2352x1568px, retinal fundus photograph:
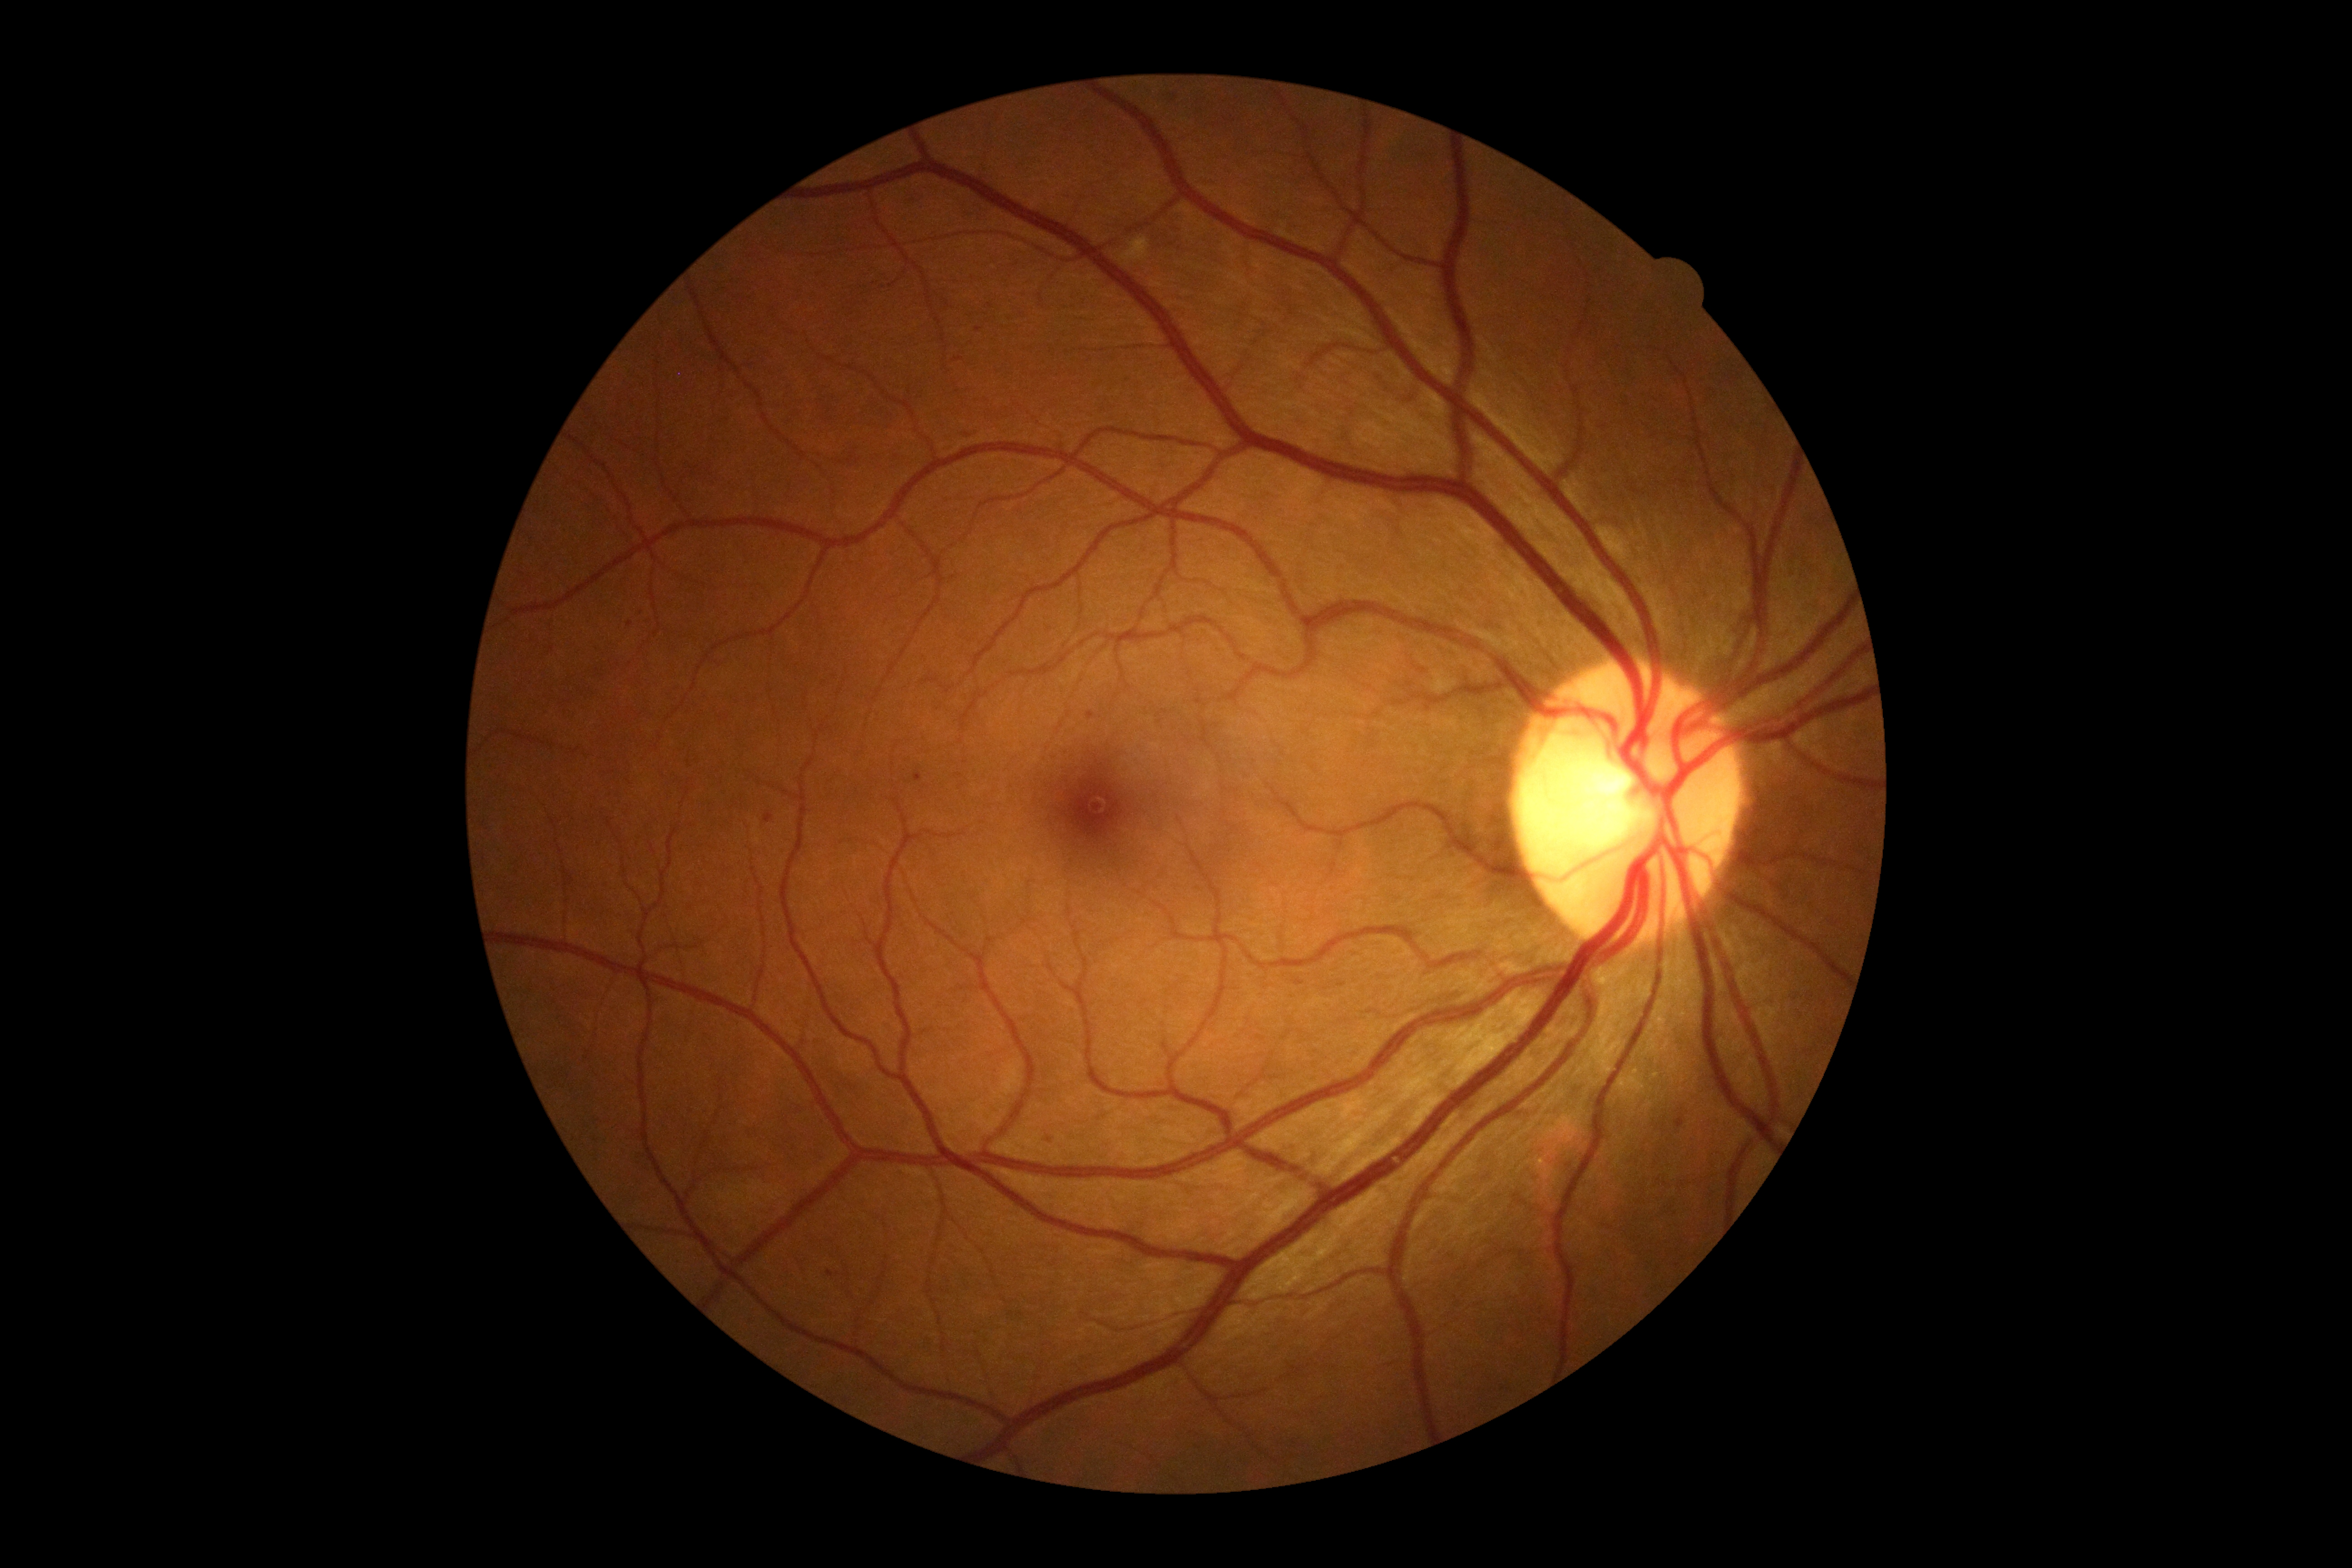

diabetic retinopathy severity: grade 2.